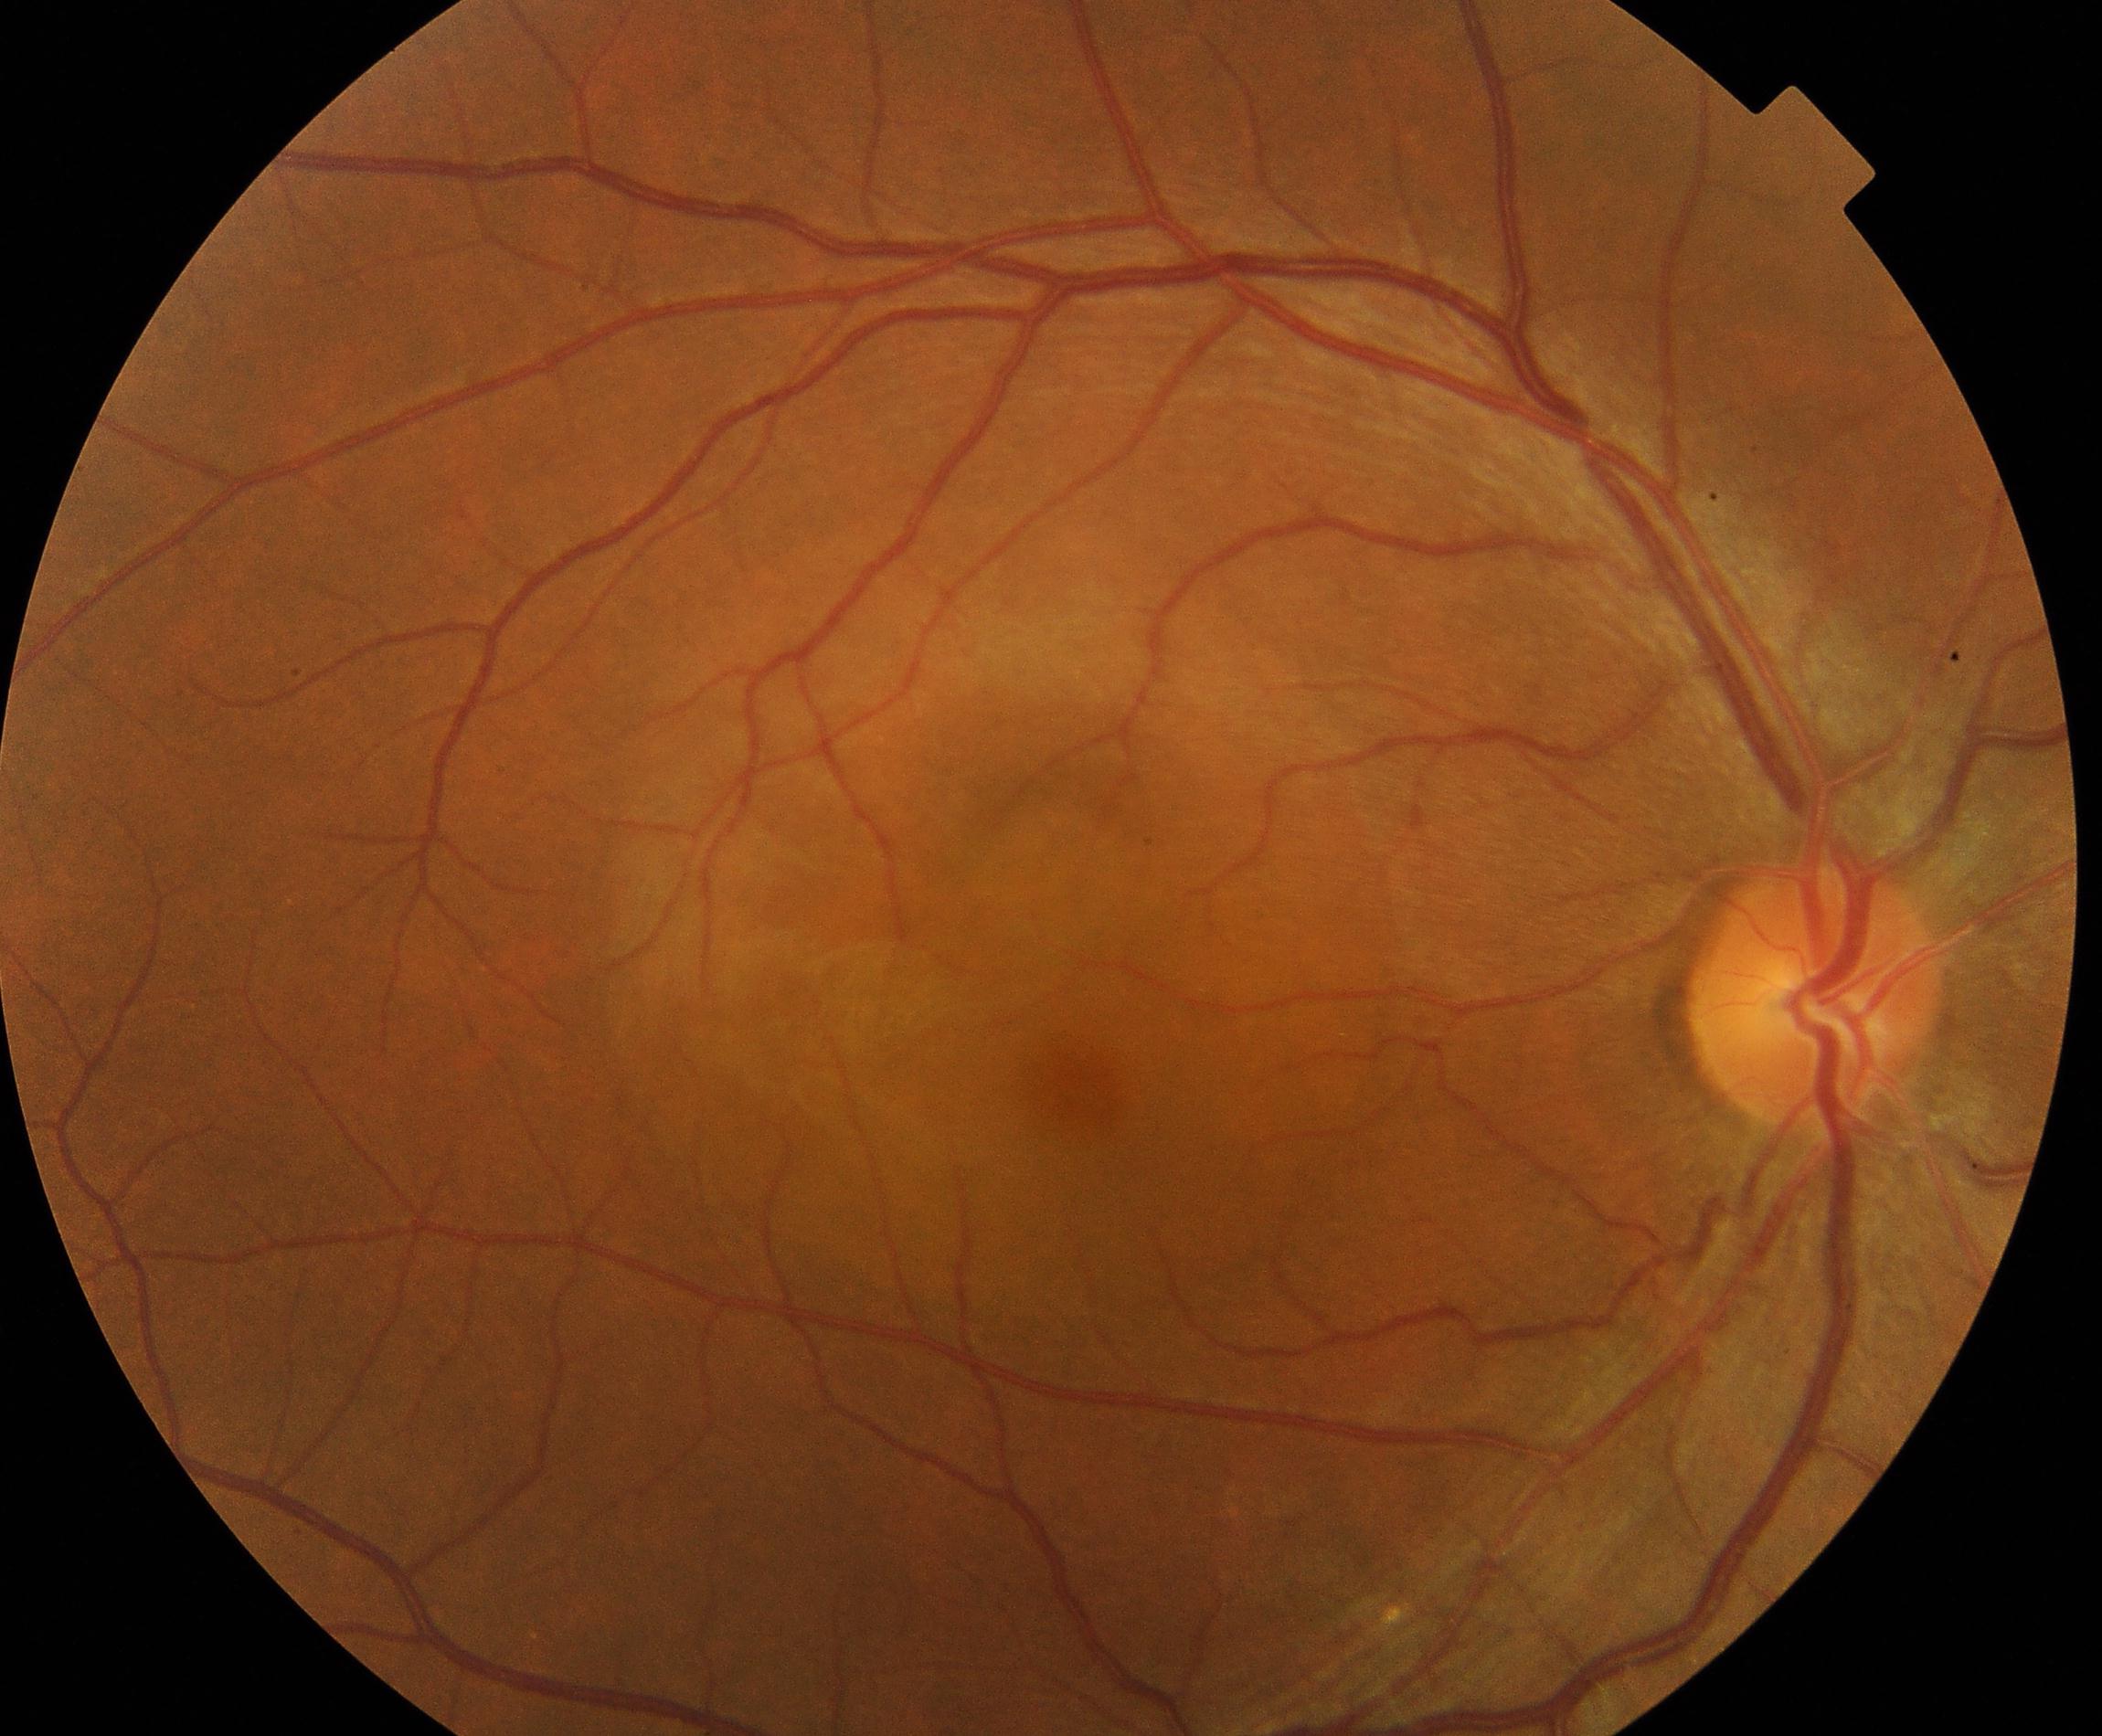

Classification: central serous chorioretinopathy (CSCR).